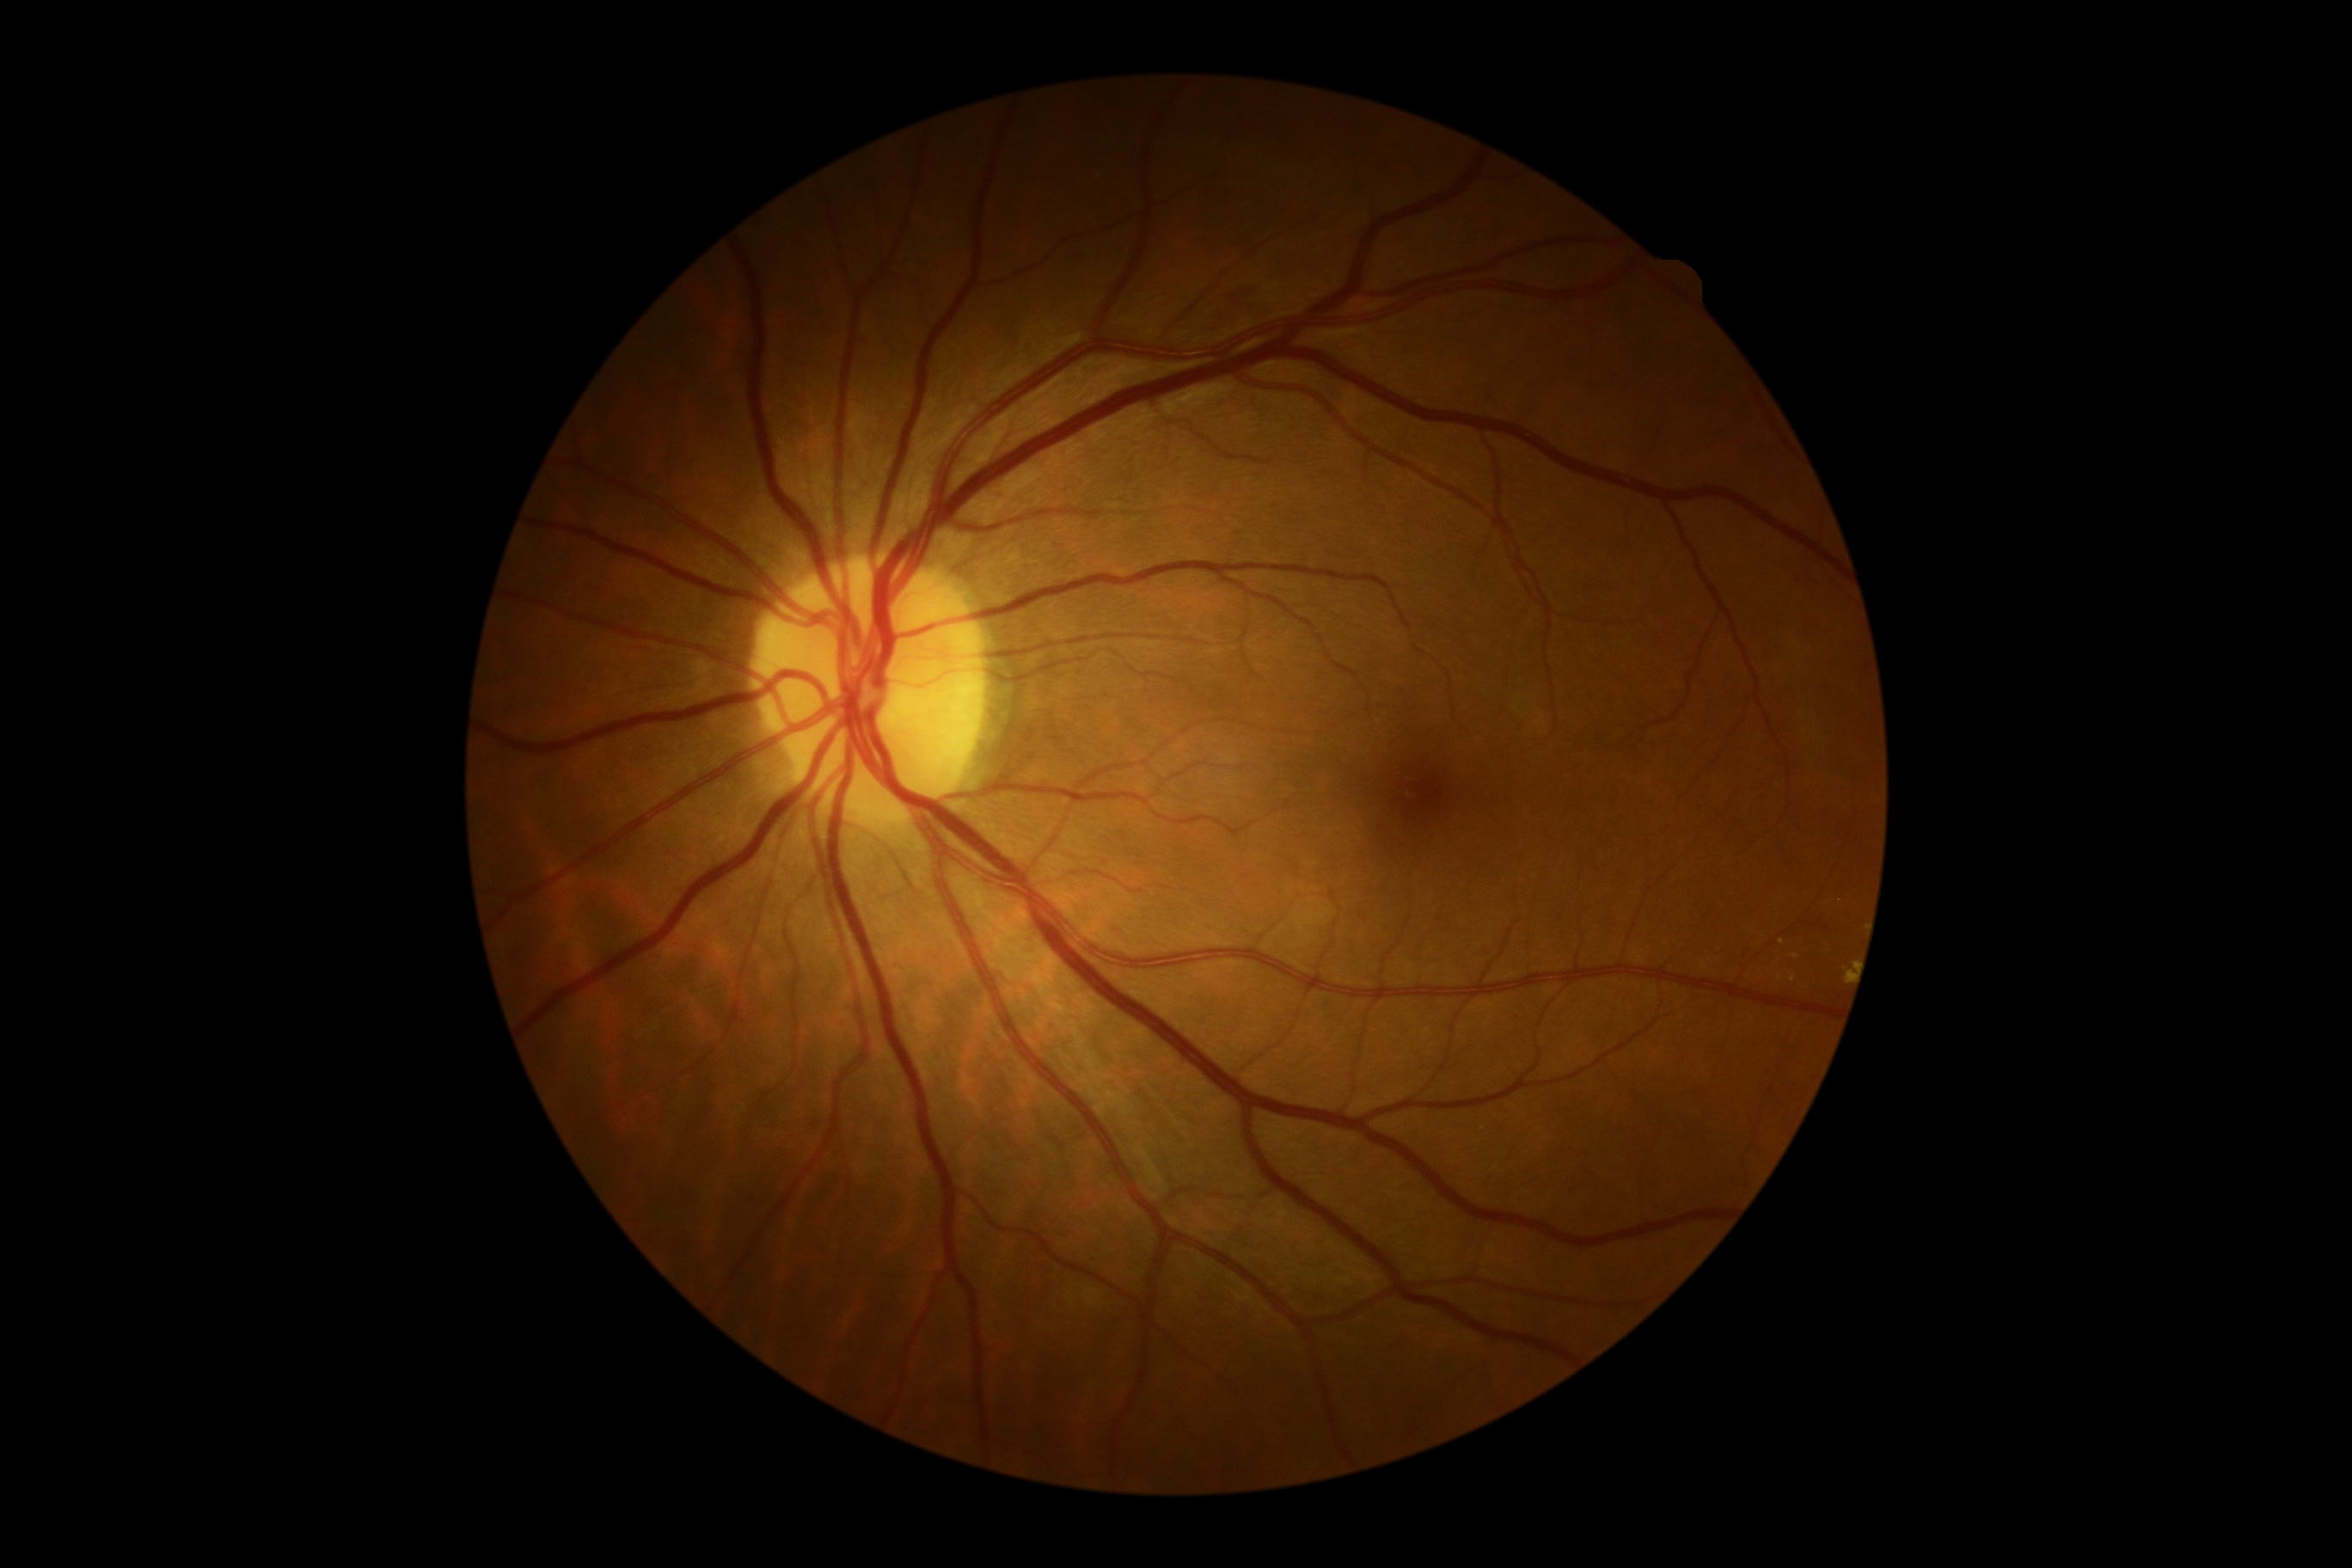
DR: 2/4.